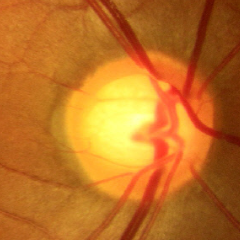
This fundus photograph shows no signs of glaucoma.